Color fundus photograph. 1932 x 1910 pixels — 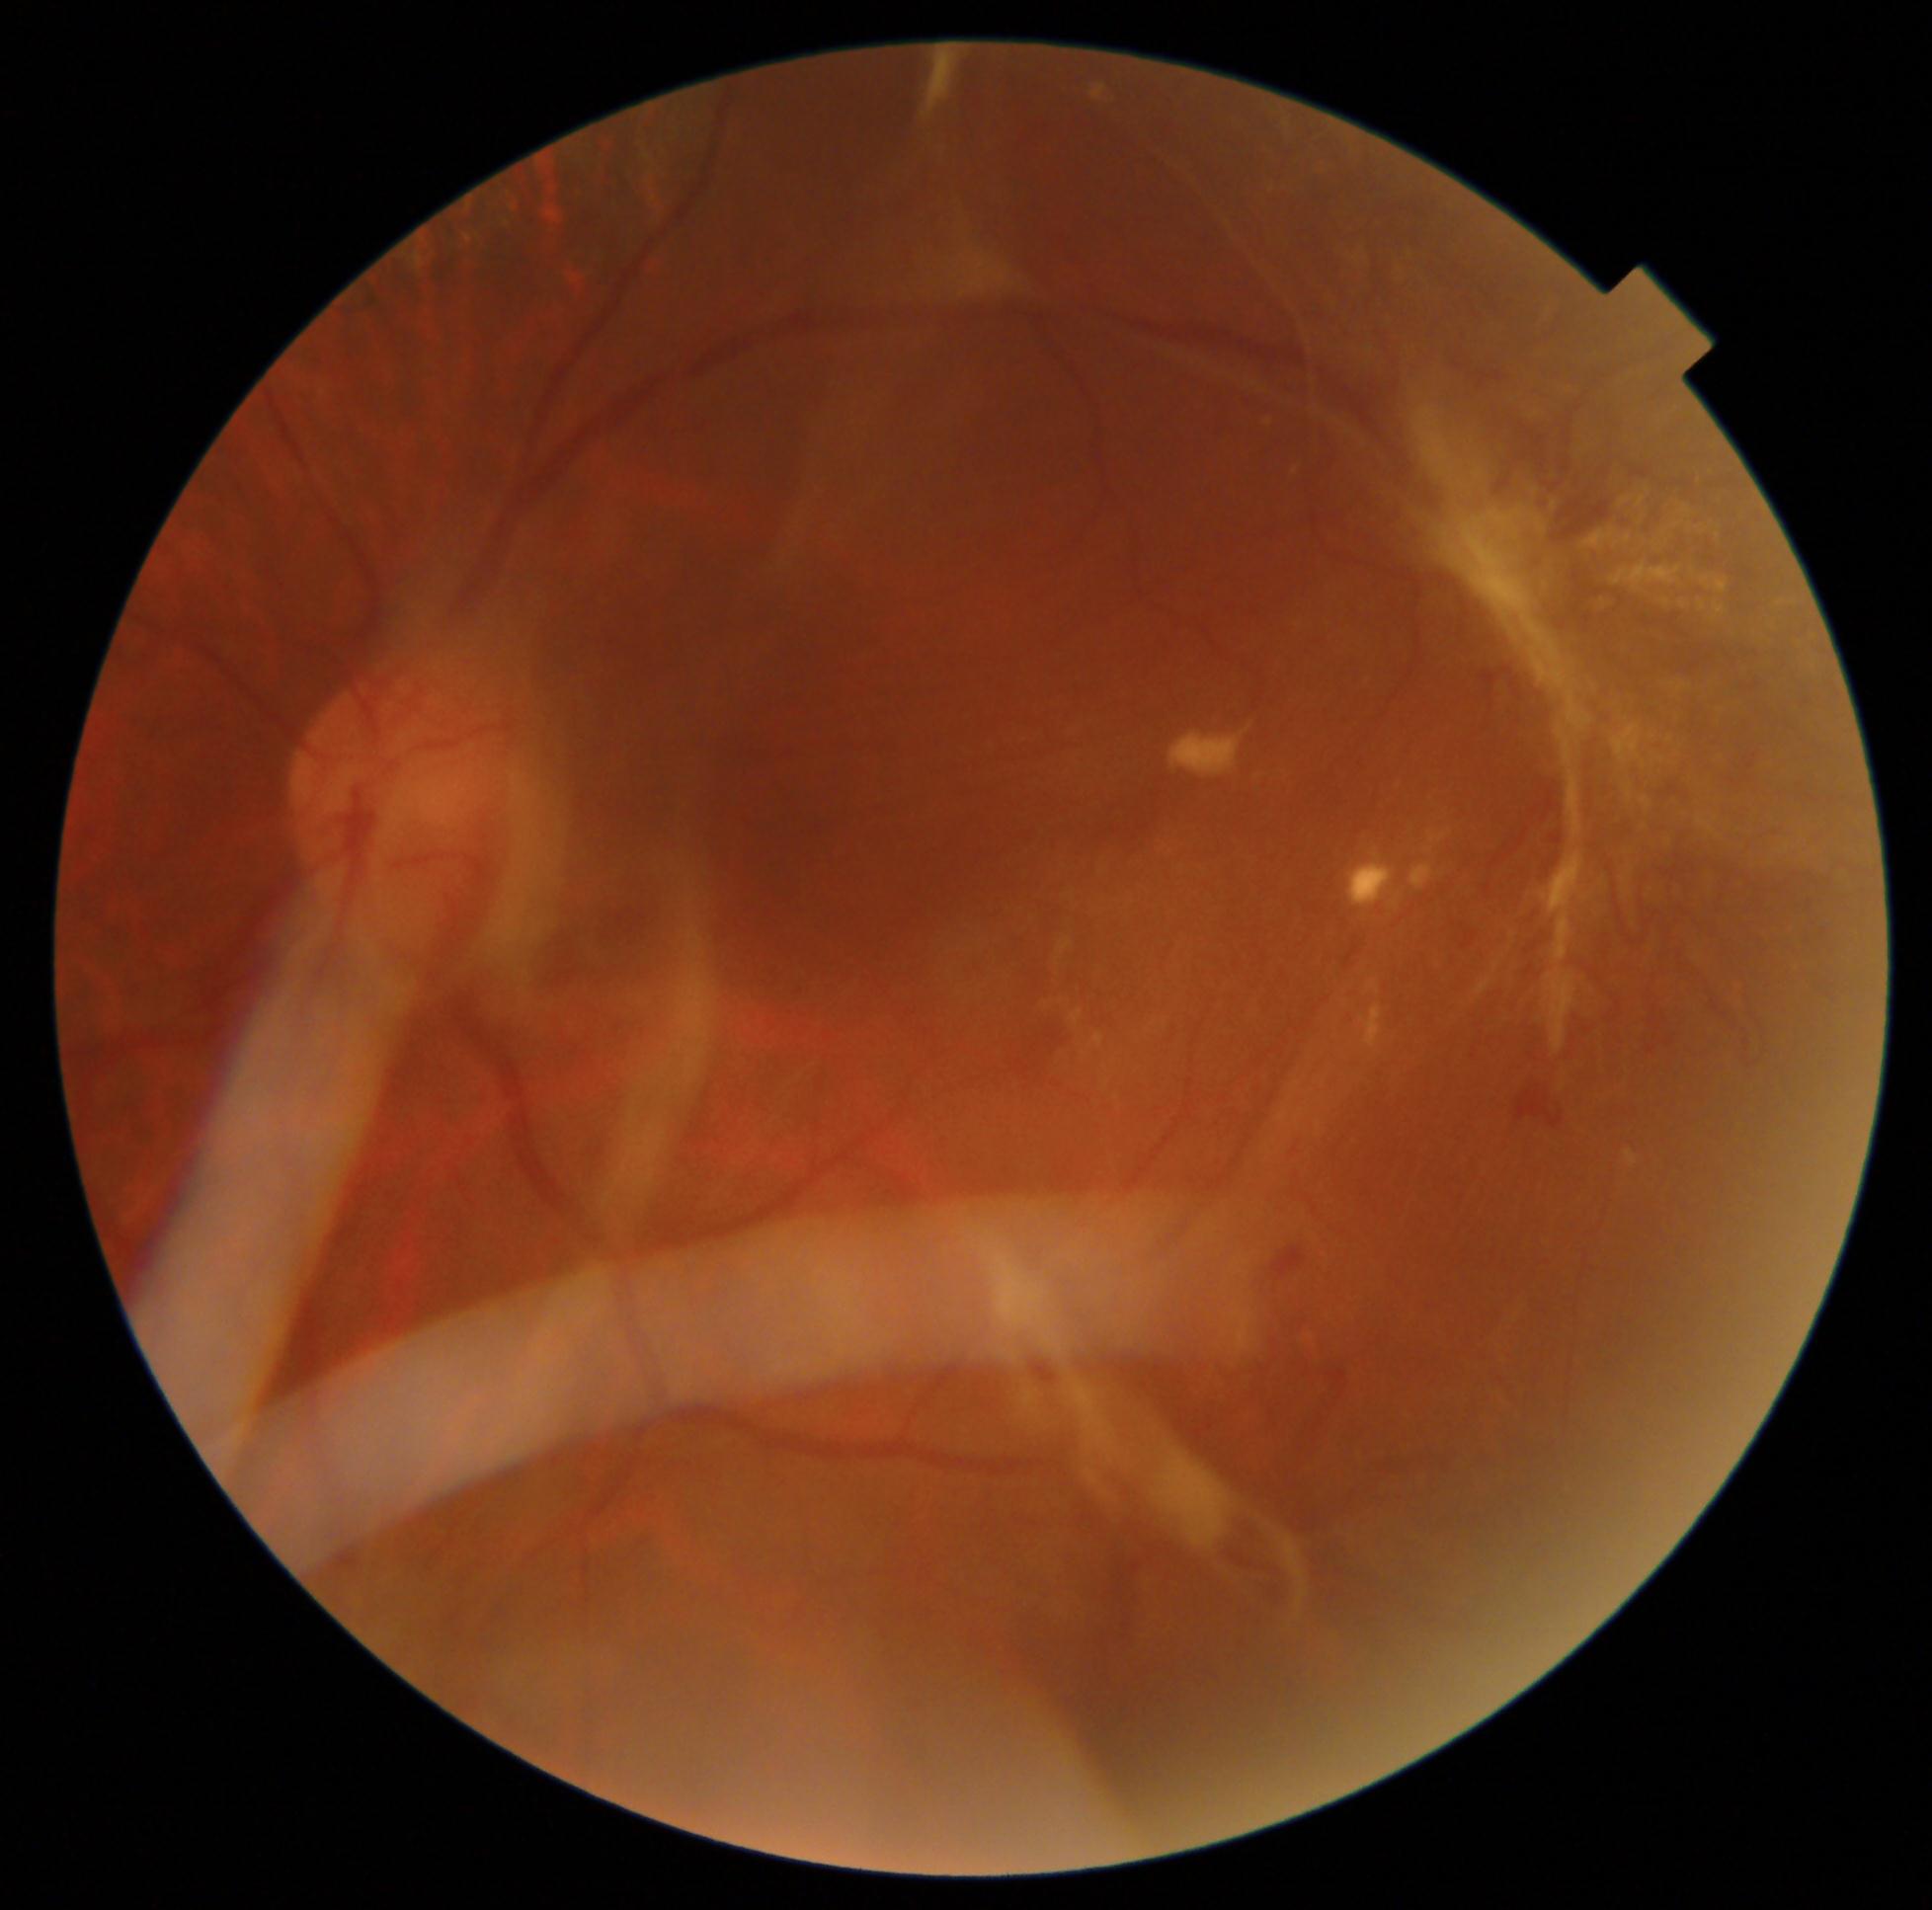 Retinopathy is grade 4 (PDR) — neovascularization and/or vitreous/pre-retinal hemorrhage. Disease class: proliferative diabetic retinopathy.